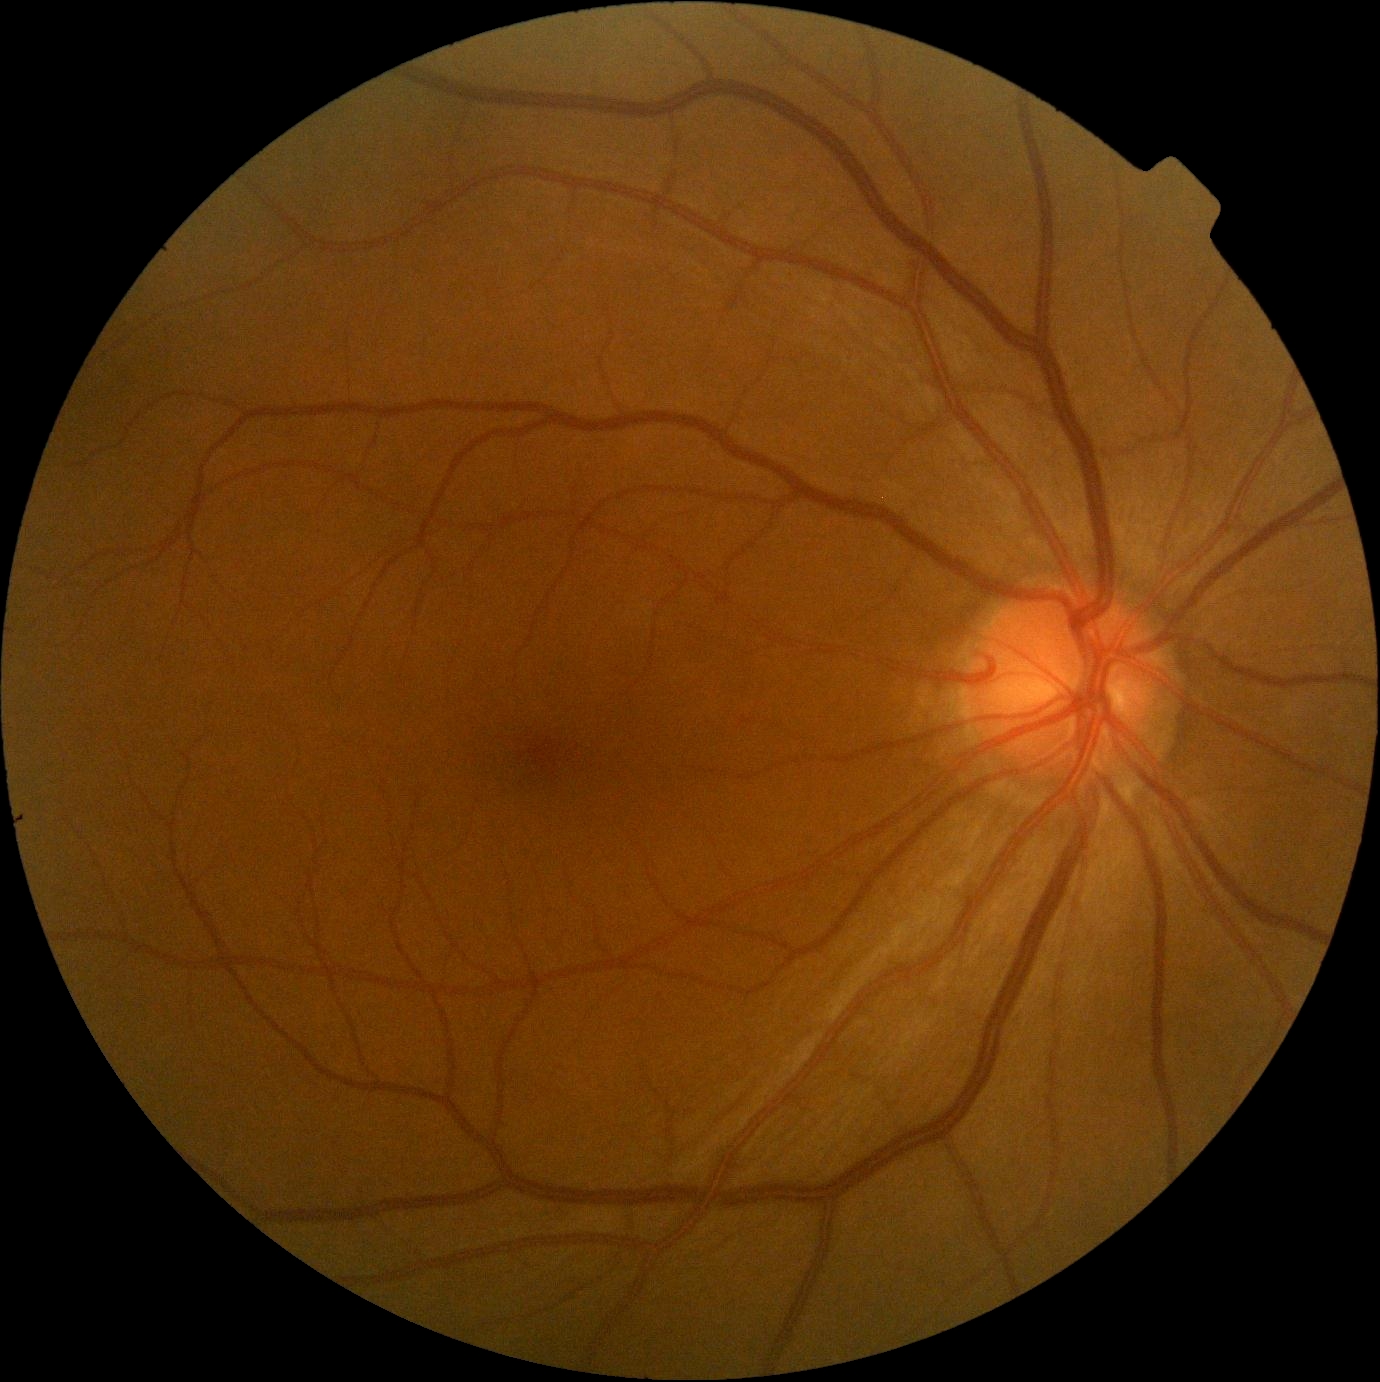

Retinopathy grade is no apparent diabetic retinopathy (0). No apparent diabetic retinopathy.